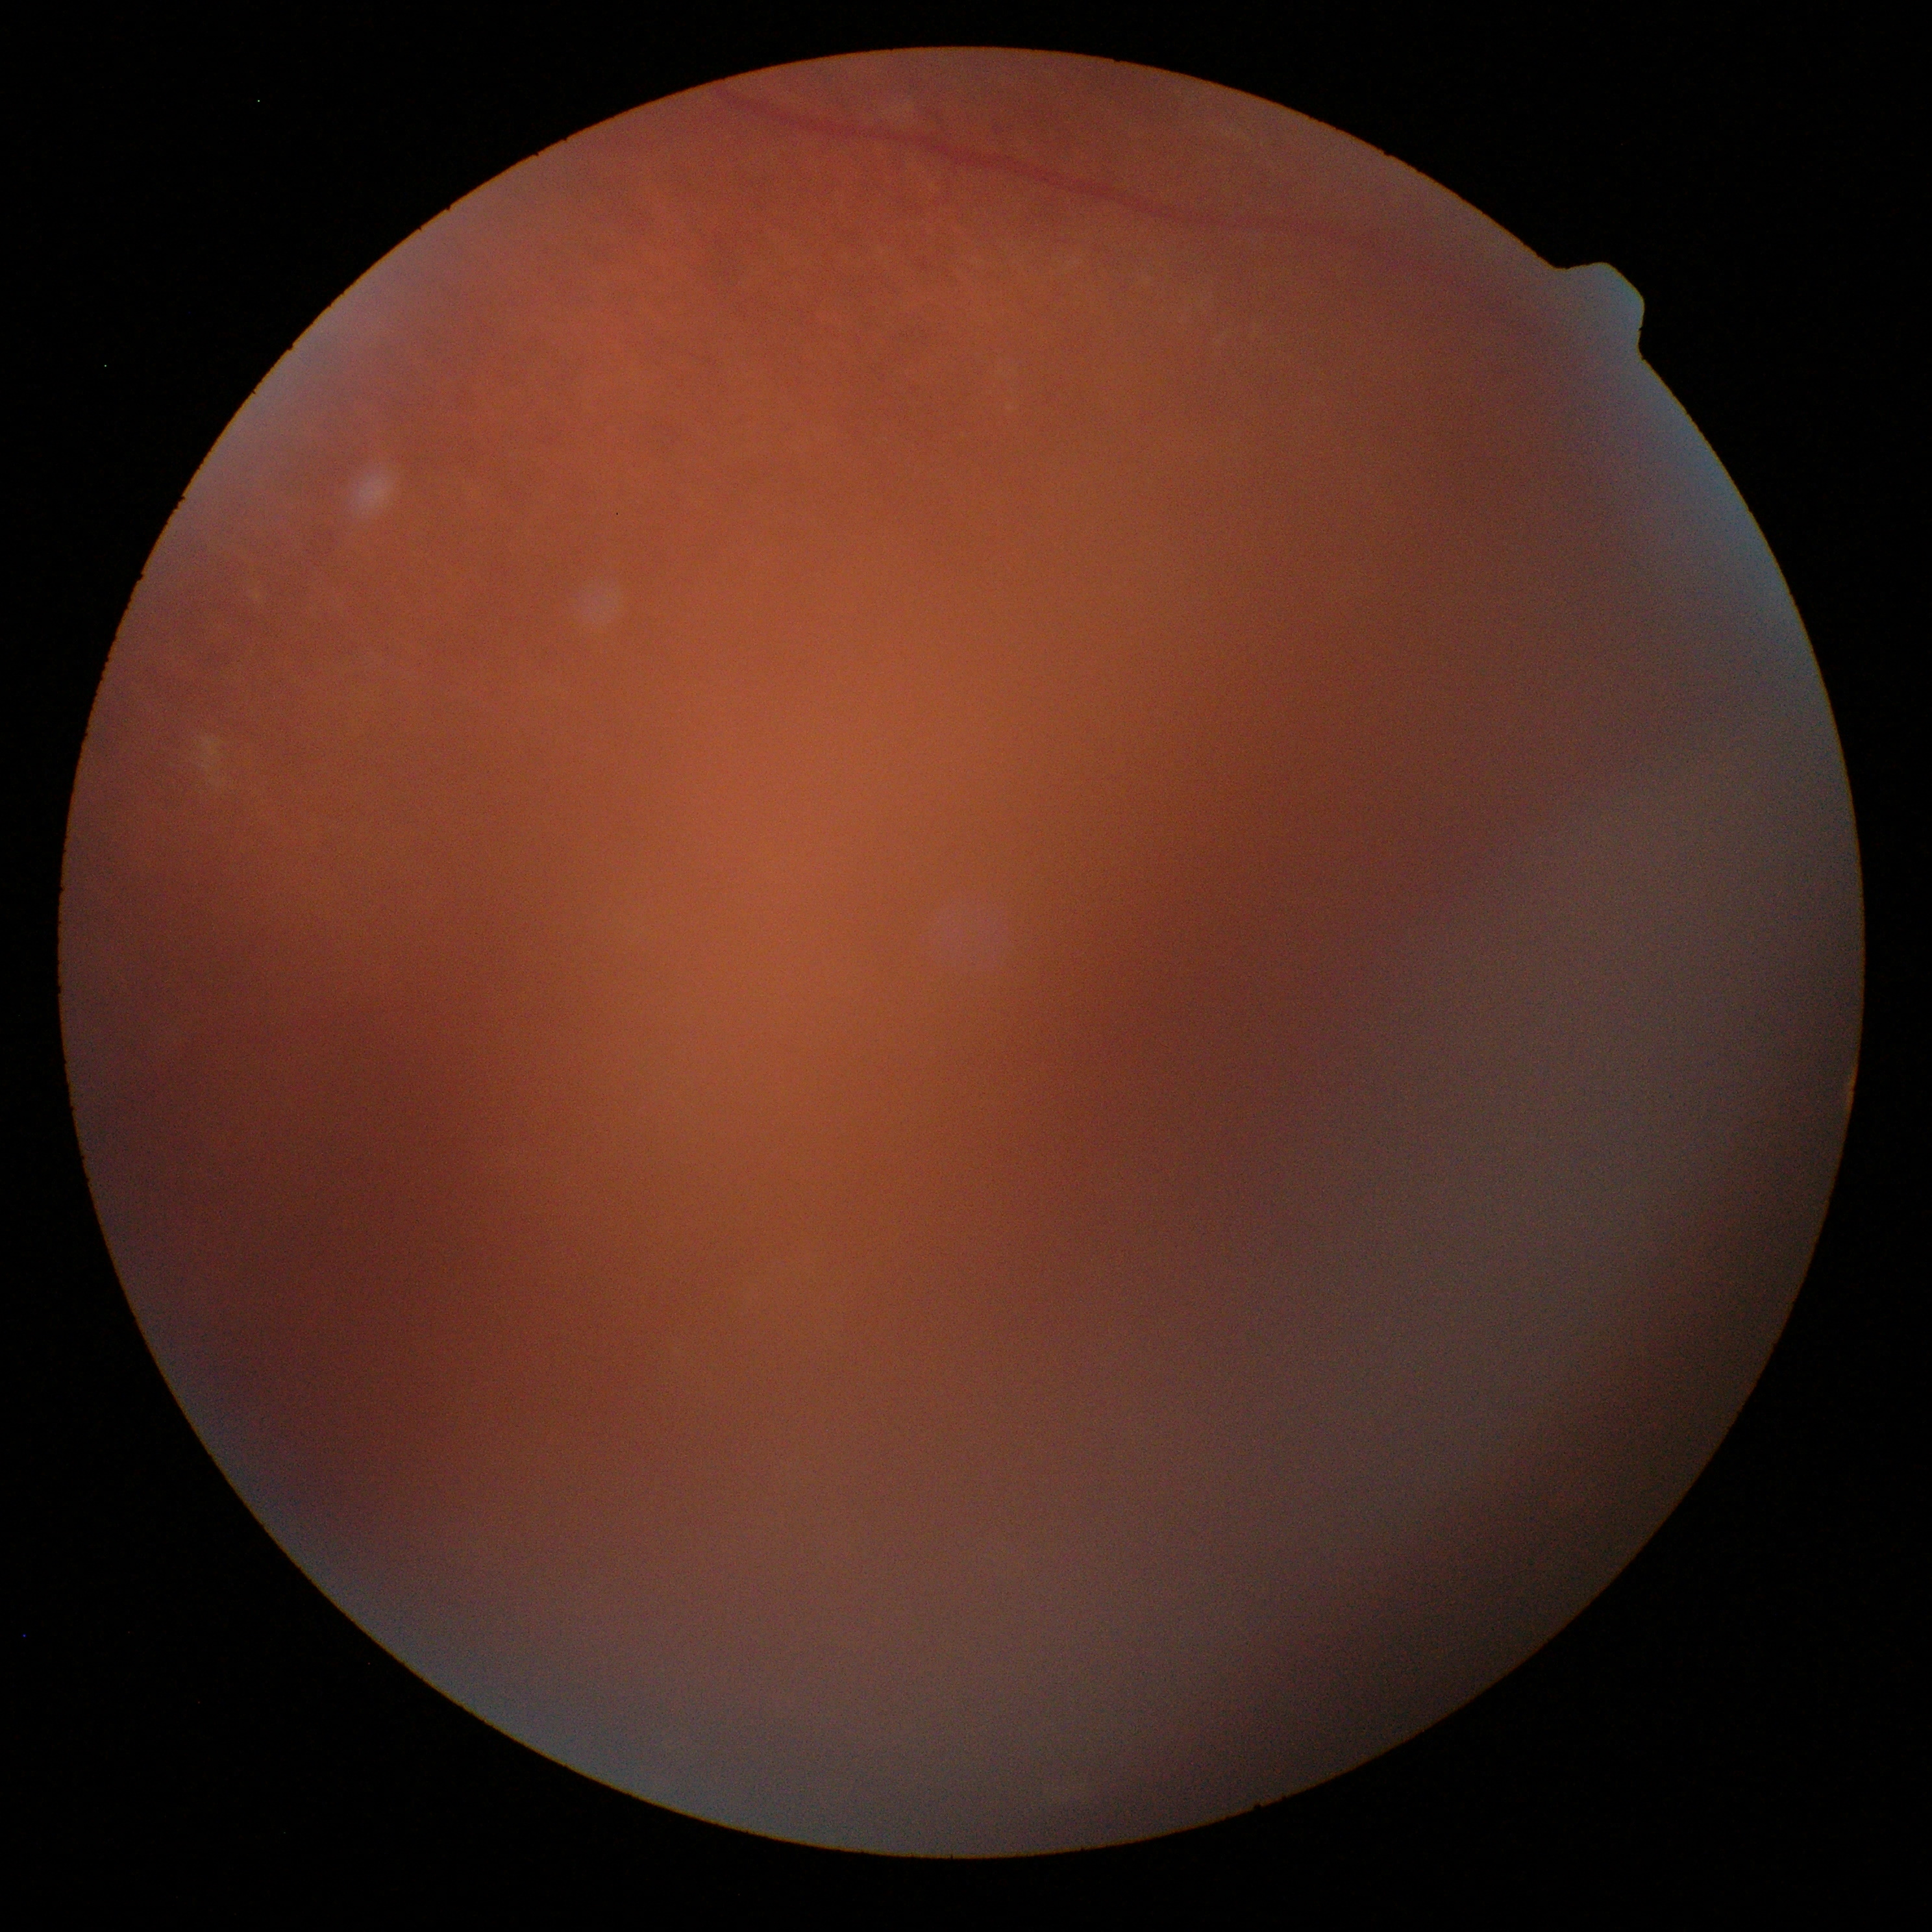

DR stage is ungradable due to poor image quality.
Image quality is insufficient for diabetic retinopathy assessment.